1923x1932px. 45° FOV: 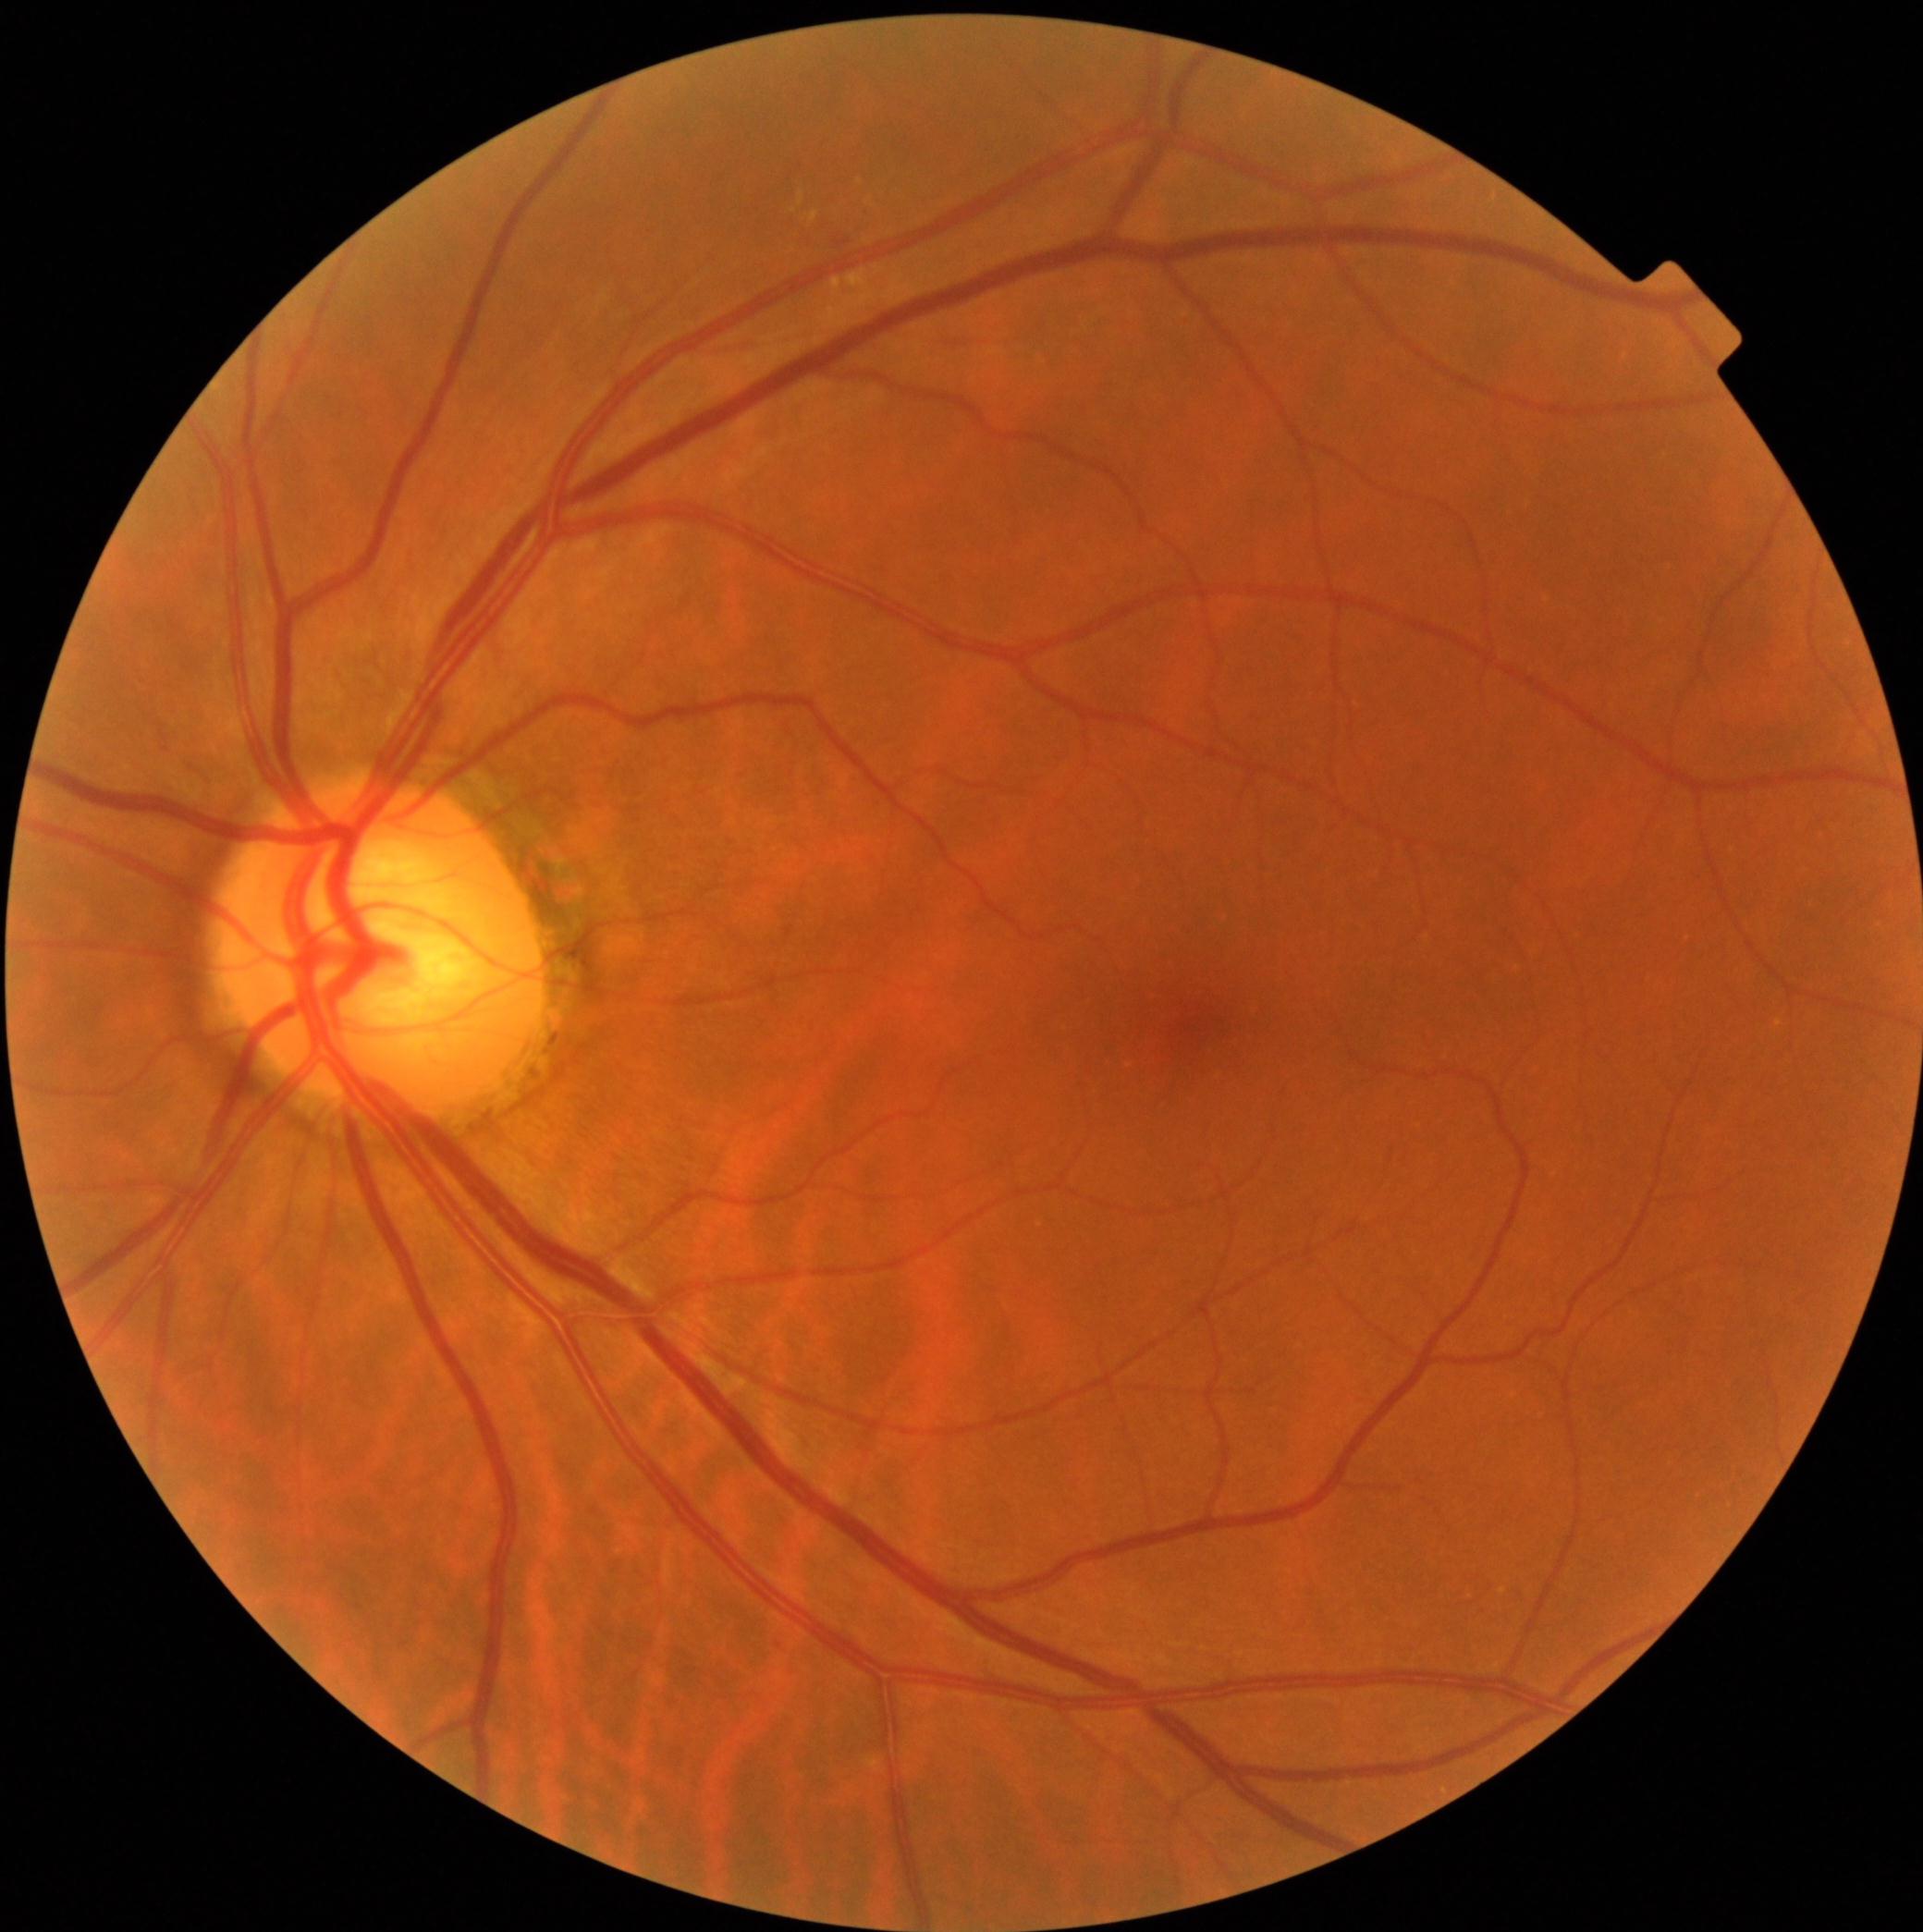 Diabetic retinopathy severity: 2.